Captured with the Natus RetCam Envision (130° field of view); wide-field fundus photograph from neonatal ROP screening; 1440 by 1080 pixels
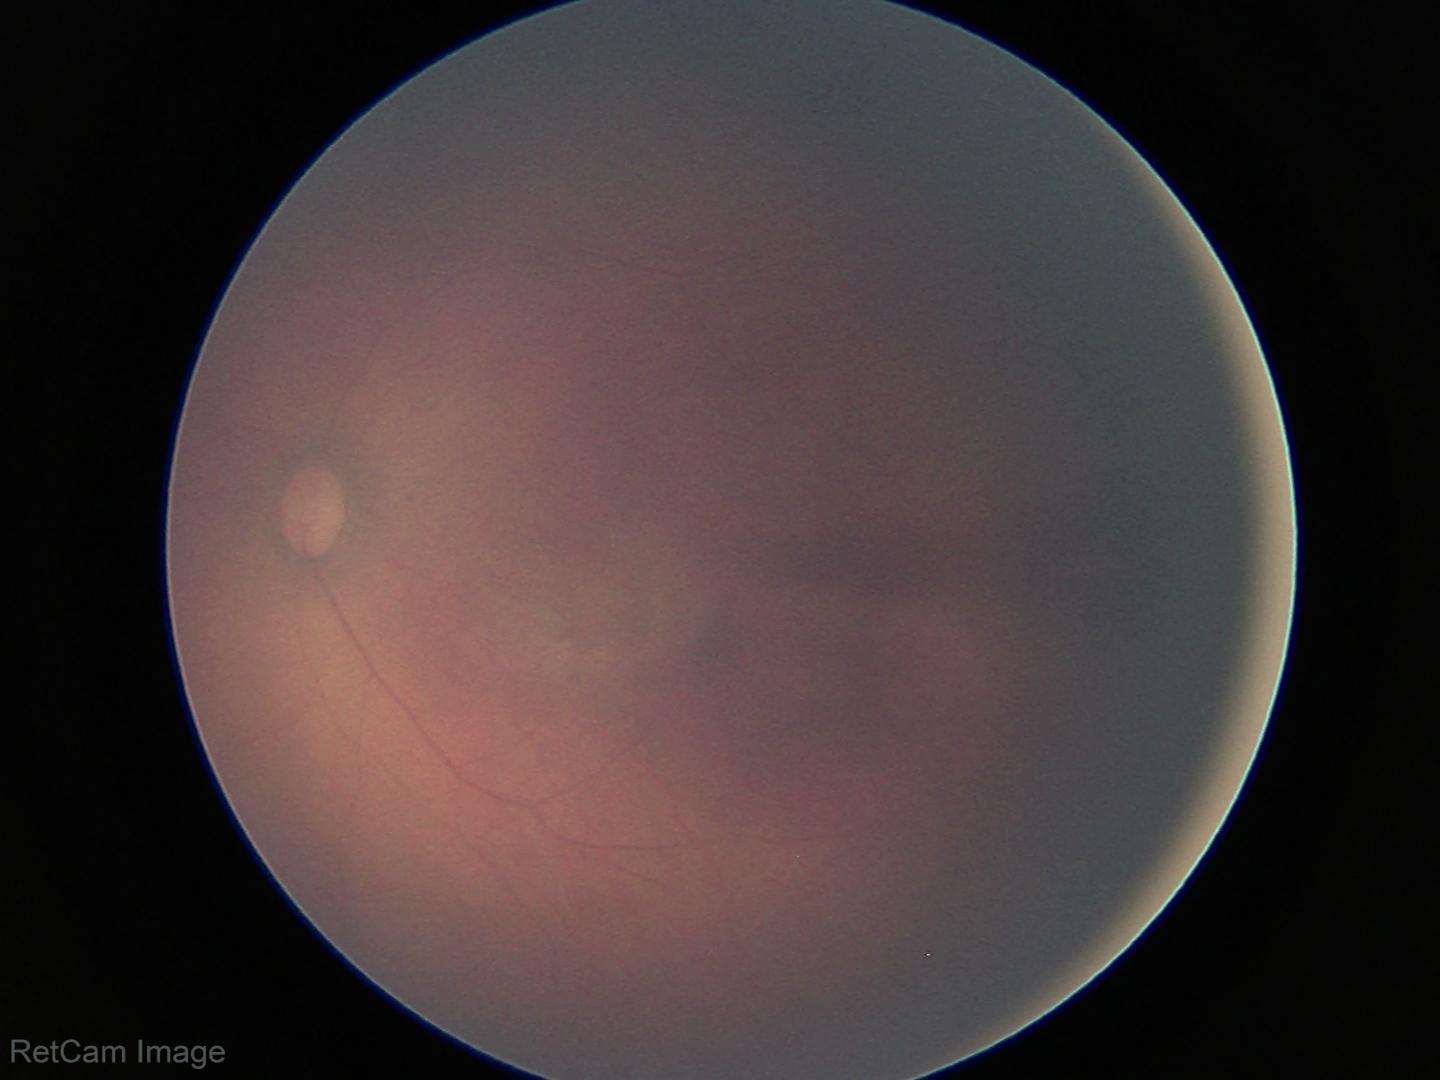

Physiological retinal appearance for postconceptual age.